Wide-field fundus photograph of an infant. Camera: Phoenix ICON (100° FOV)
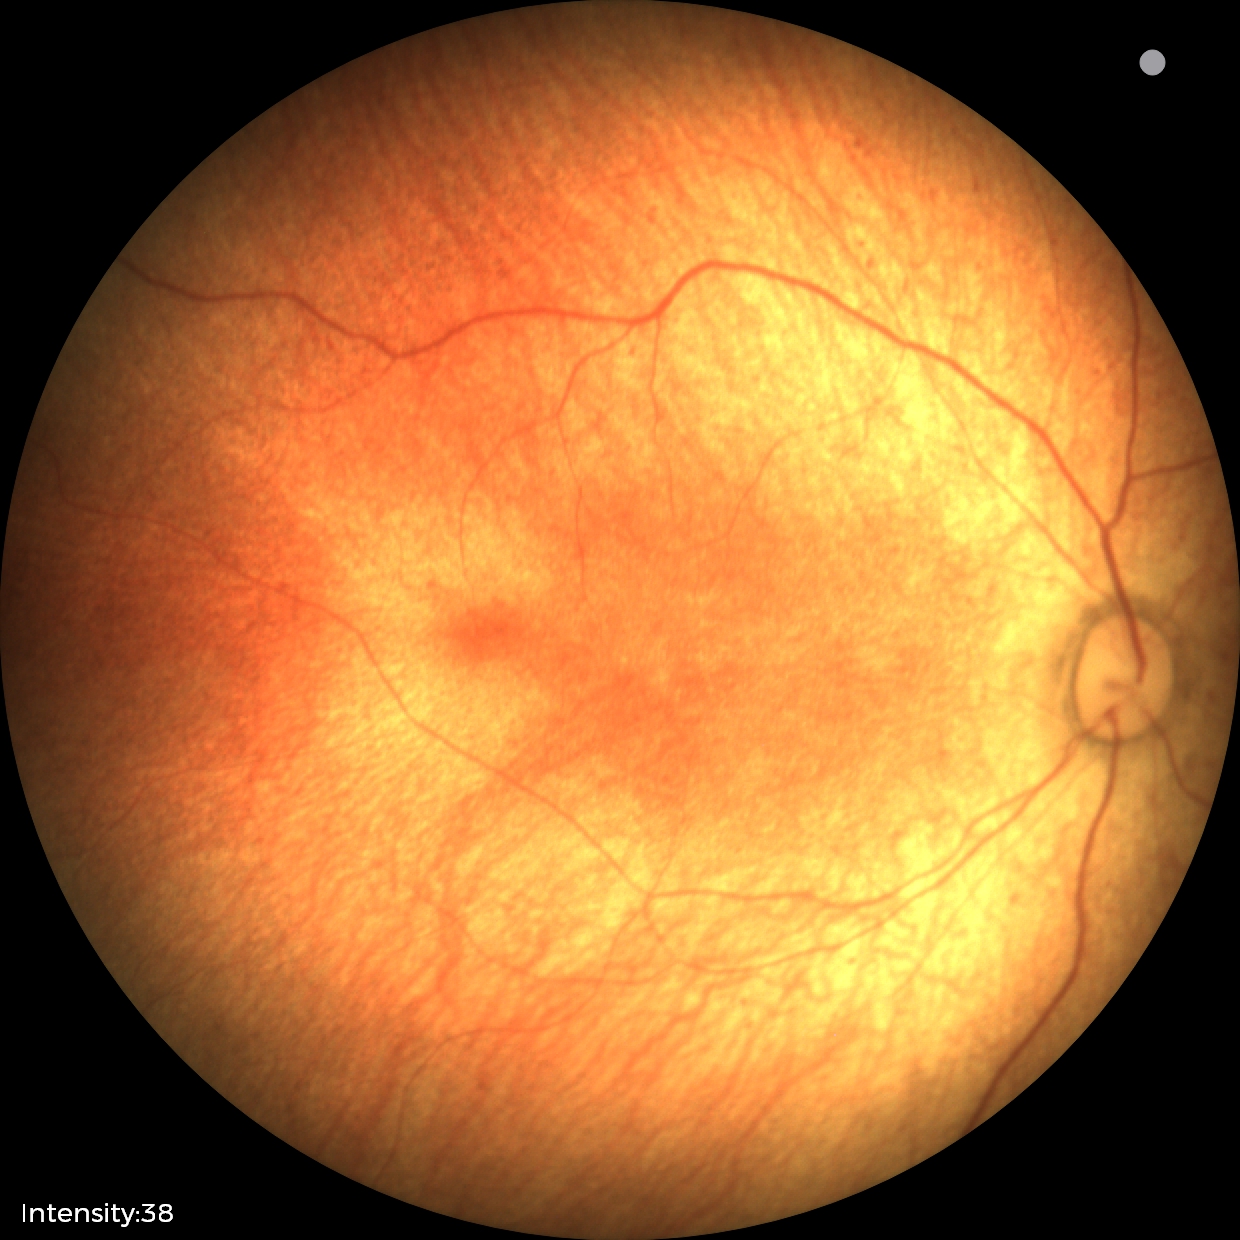 Q: What is the screening diagnosis?
A: physiological finding